Infant wide-field fundus photograph. 1440x1080px — 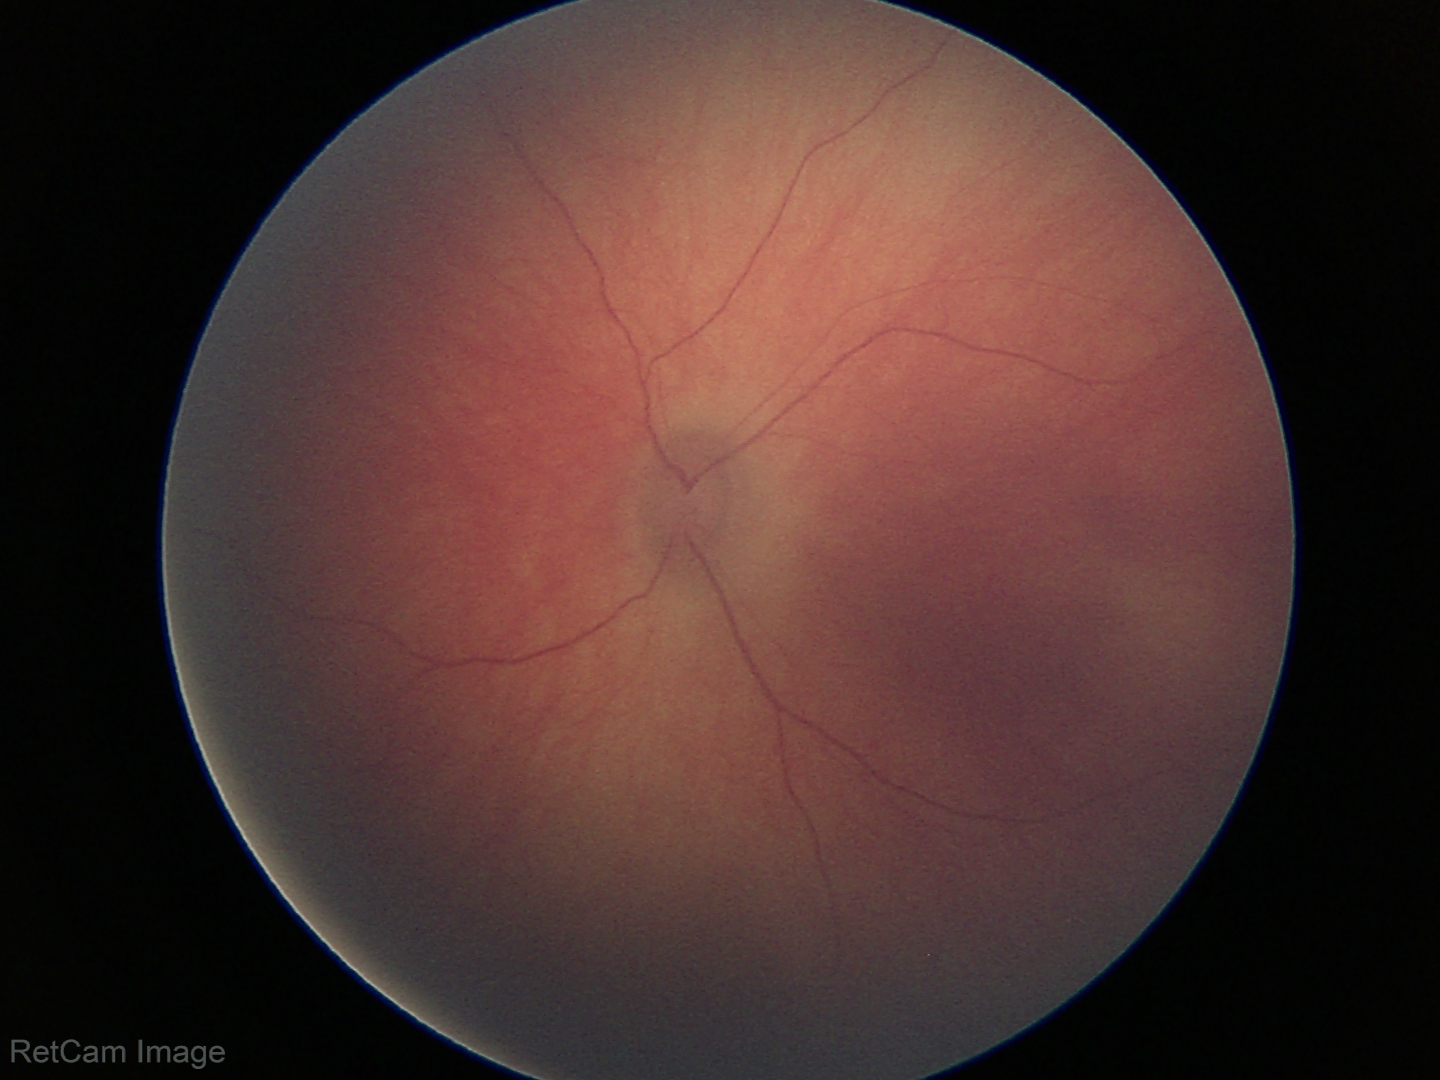 Screening diagnosis: physiological retinal finding.